640 x 480 pixels · RetCam wide-field infant fundus image: 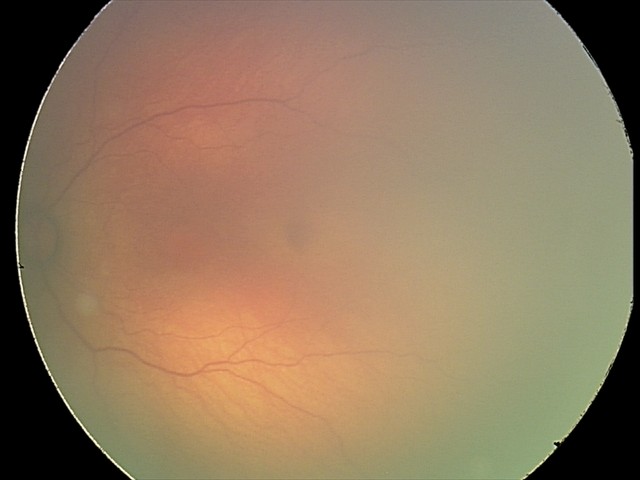

Plus form = absent
finding = status post retinopathy of prematurity (ROP)